Wide-field fundus photograph from neonatal ROP screening
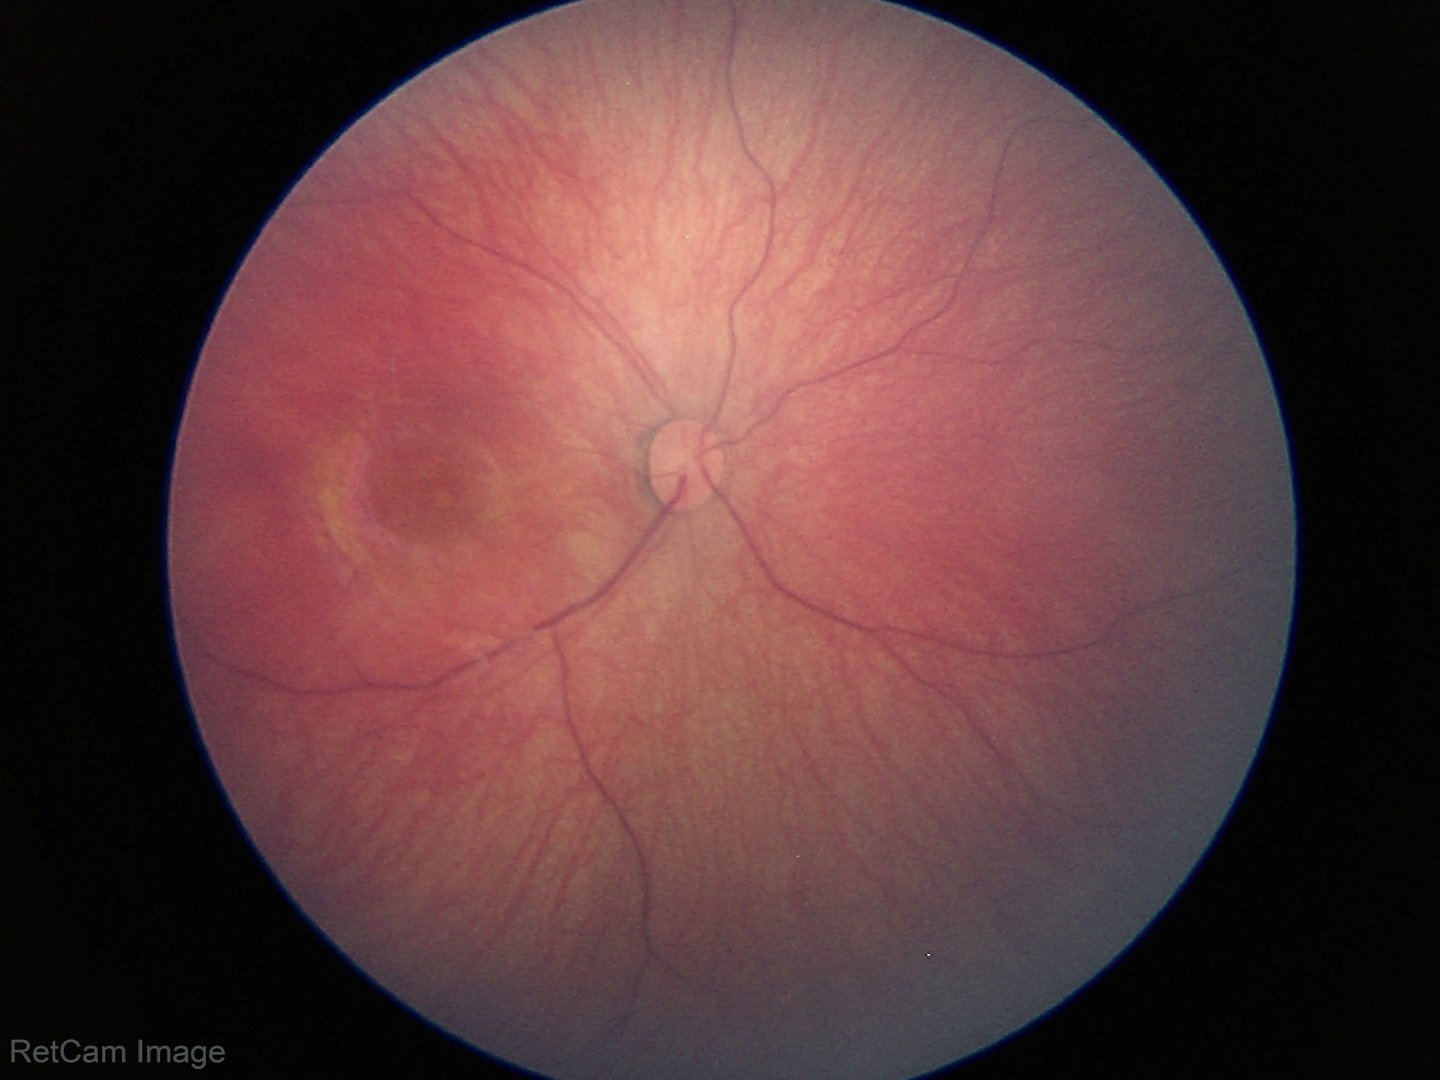

Screening examination diagnosed as physiological.